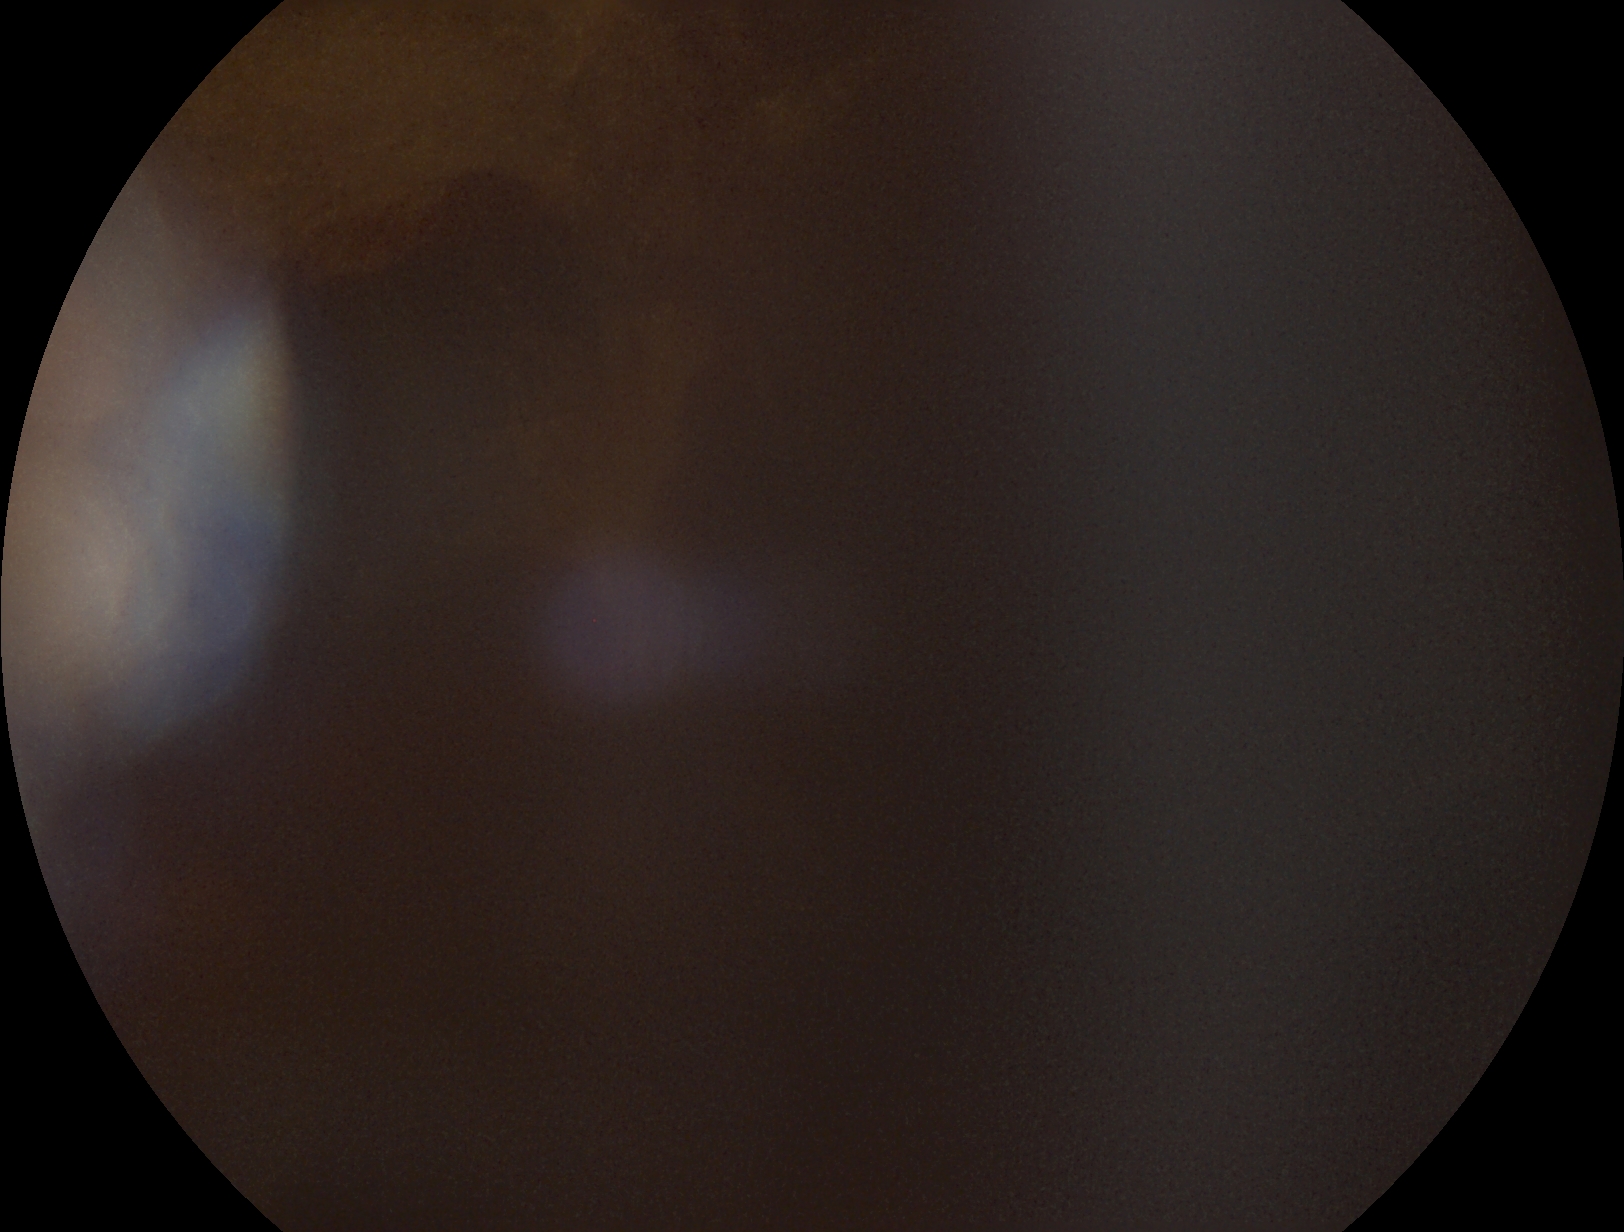 Diabetic retinopathy (DR) is 4.